Acquired on the Clarity RetCam 3; infant wide-field retinal image: 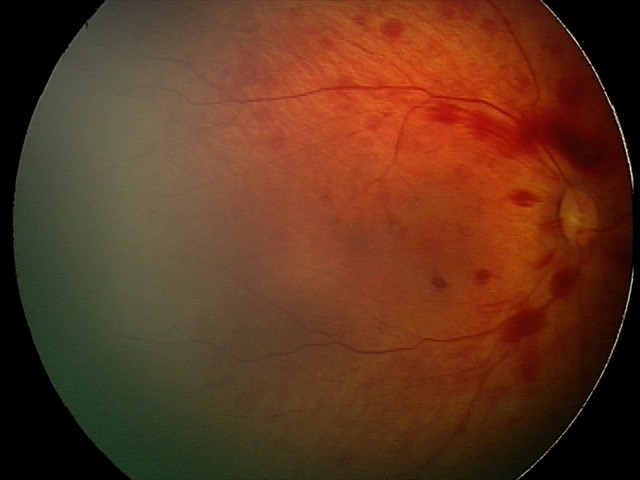

Assessment: retinal hemorrhages.